Graded on the modified Davis scale — 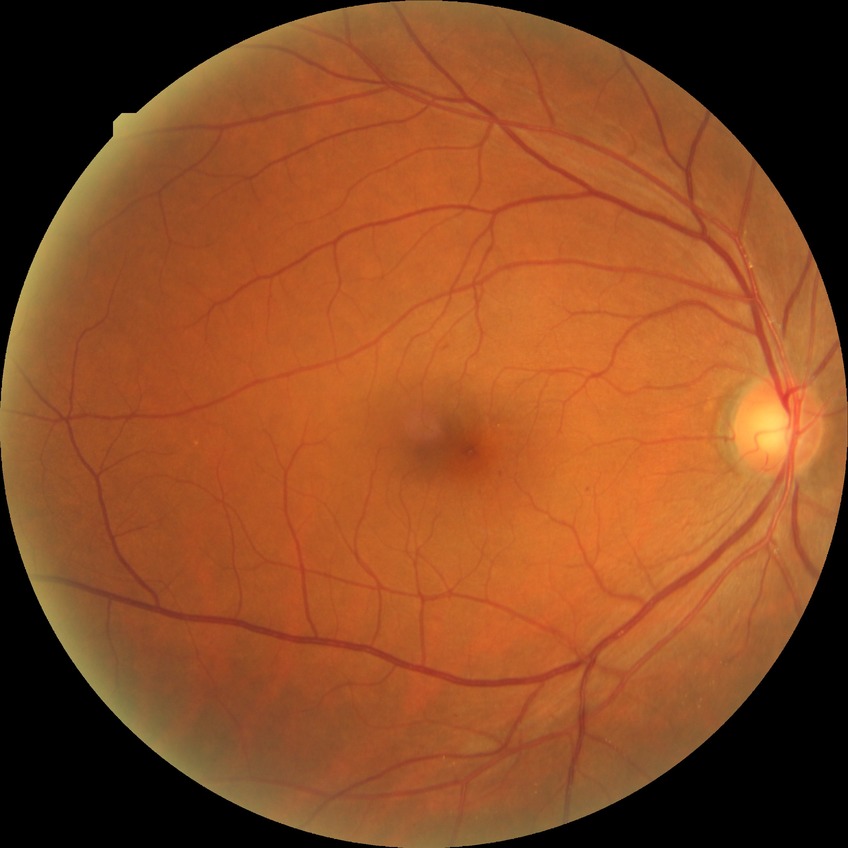
• diabetic retinopathy grade: no diabetic retinopathy